130° field of view (Clarity RetCam 3) · 640 x 480 pixels · RetCam wide-field infant fundus image
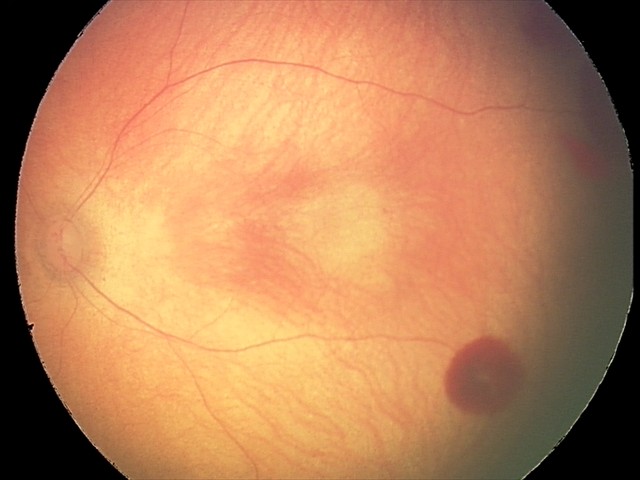
Diagnosis from this screening exam: retinal hemorrhages.